Camera: Topcon TRC-NW8 — 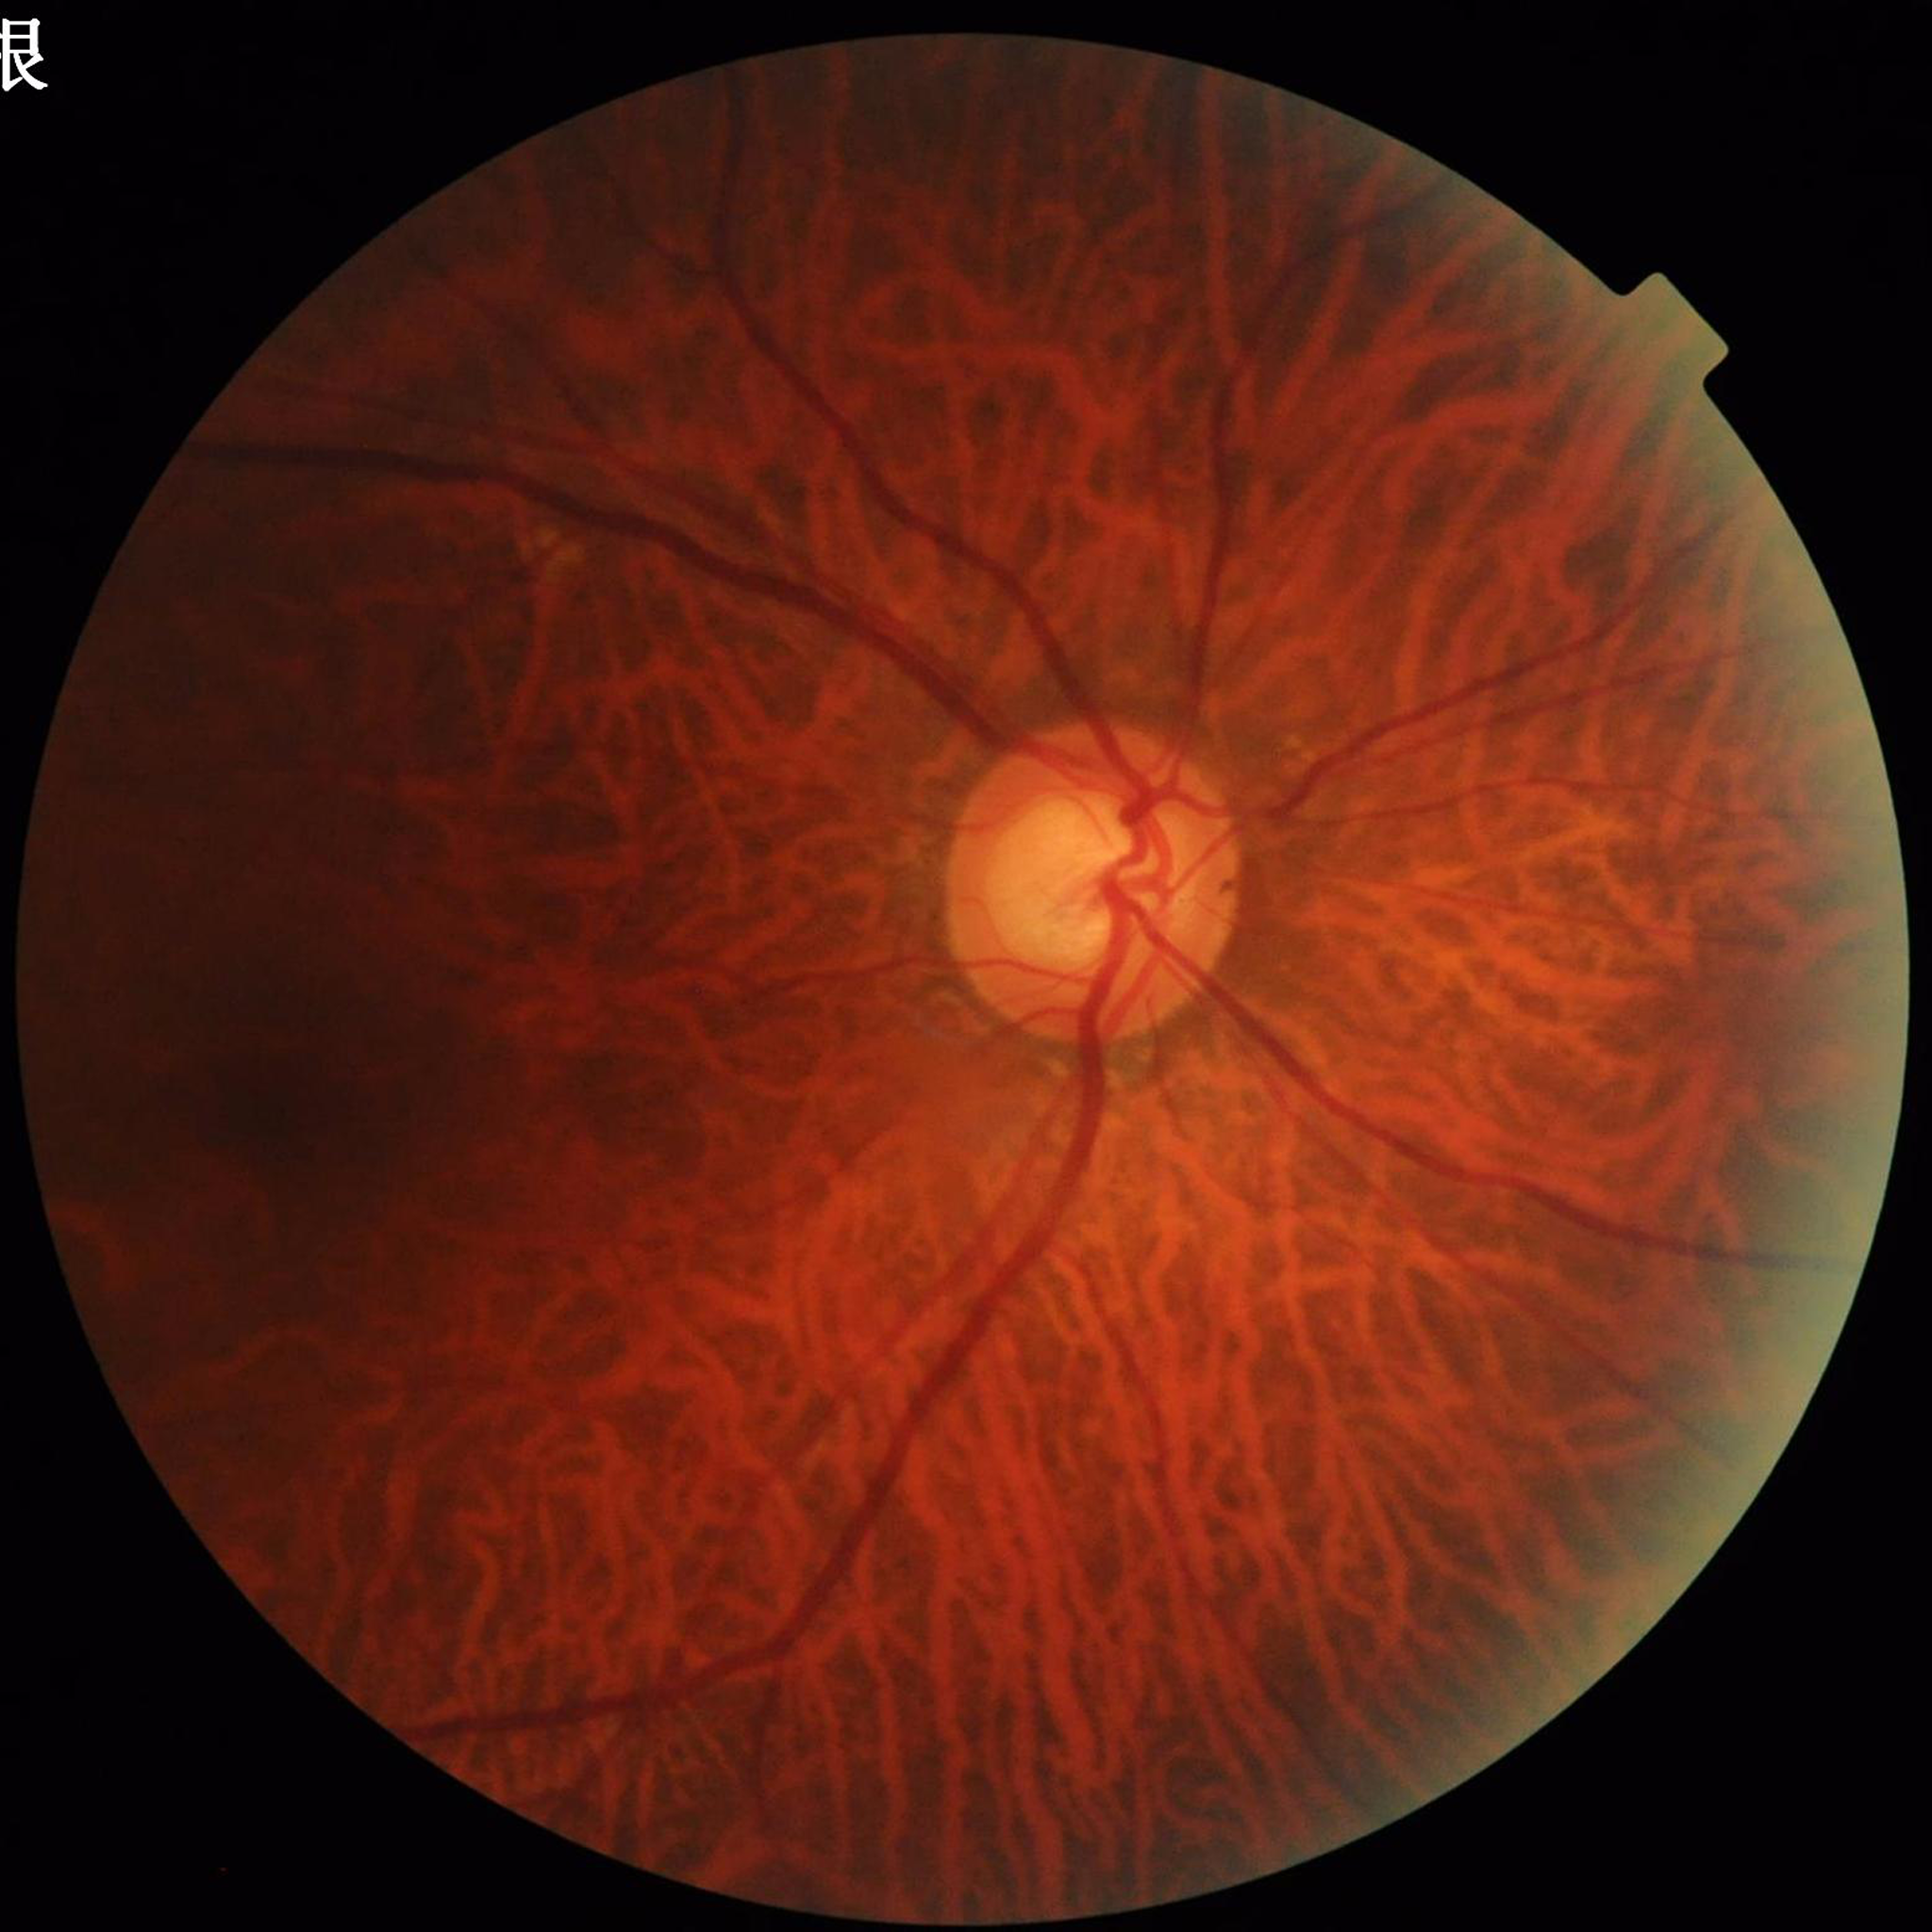 Disease: glaucoma.